FOV: 60 degrees; handheld portable fundus camera image — 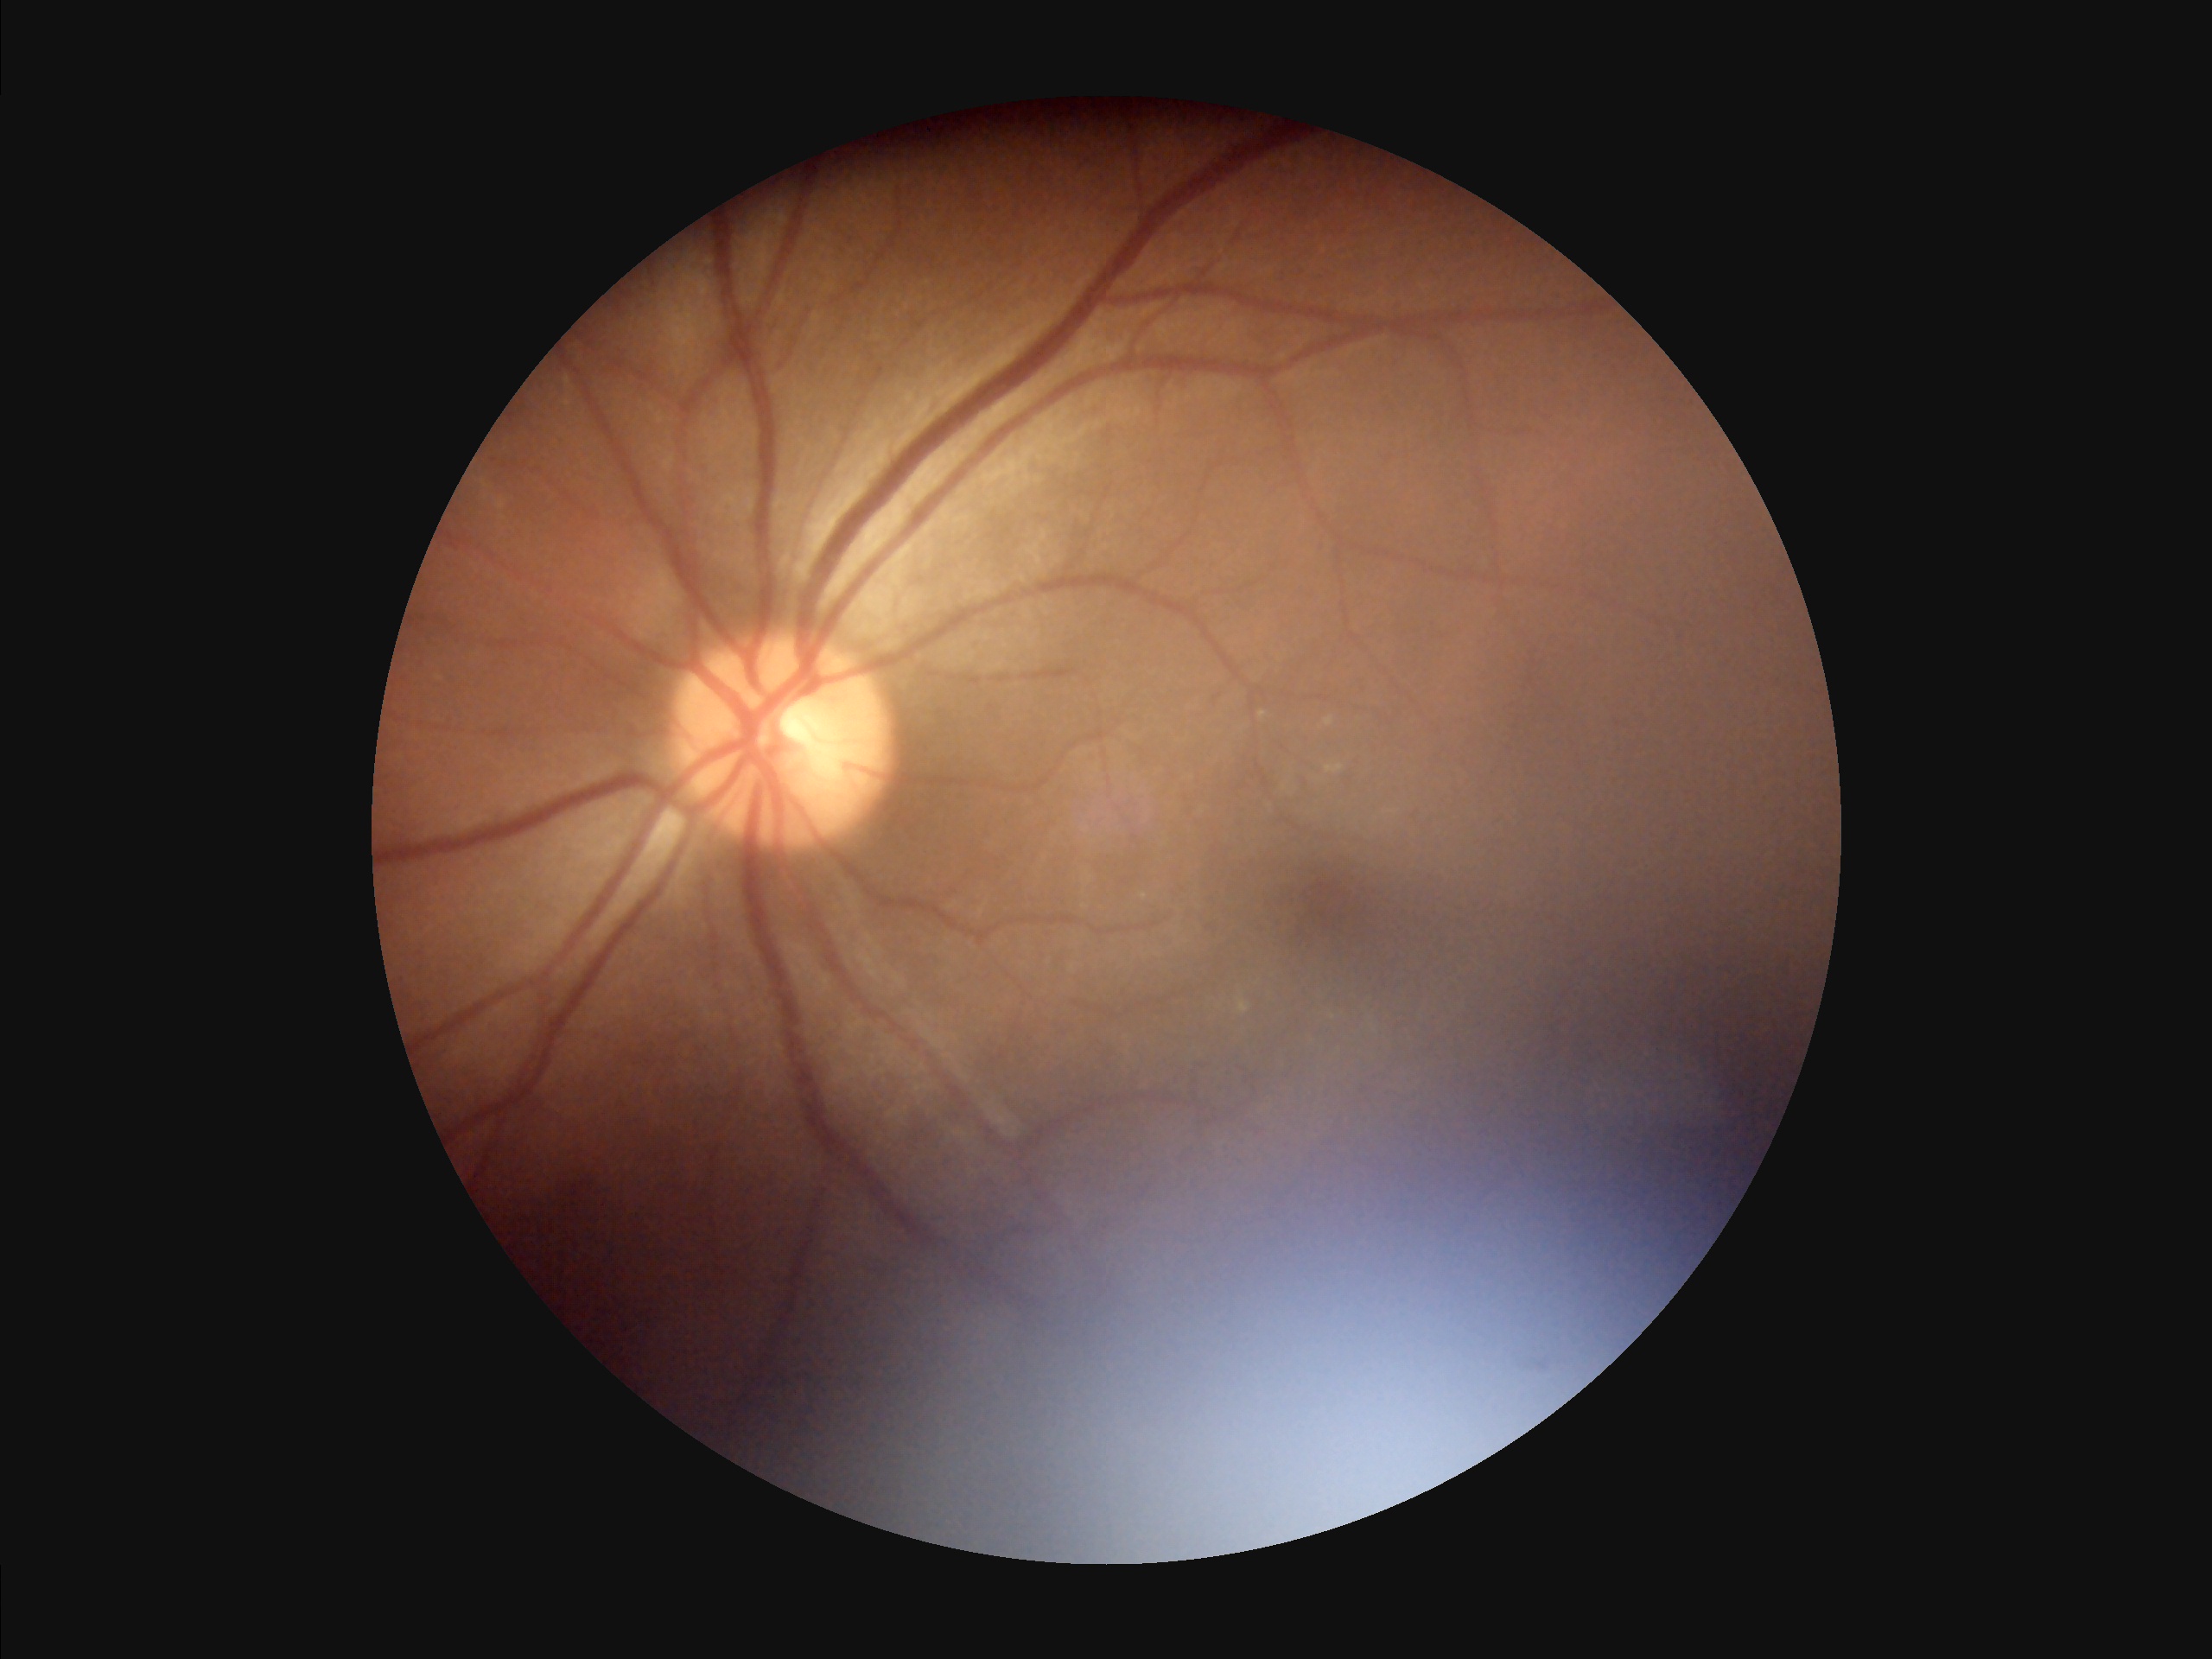 Quality grading: overall: poor and difficult to use diagnostically | focus: out of focus, structures indistinct | illumination/color: uneven illumination or color cast | contrast: wide intensity range, structures distinguishable.